1240 x 1240 pixels. Phoenix ICON wide-field infant fundus image
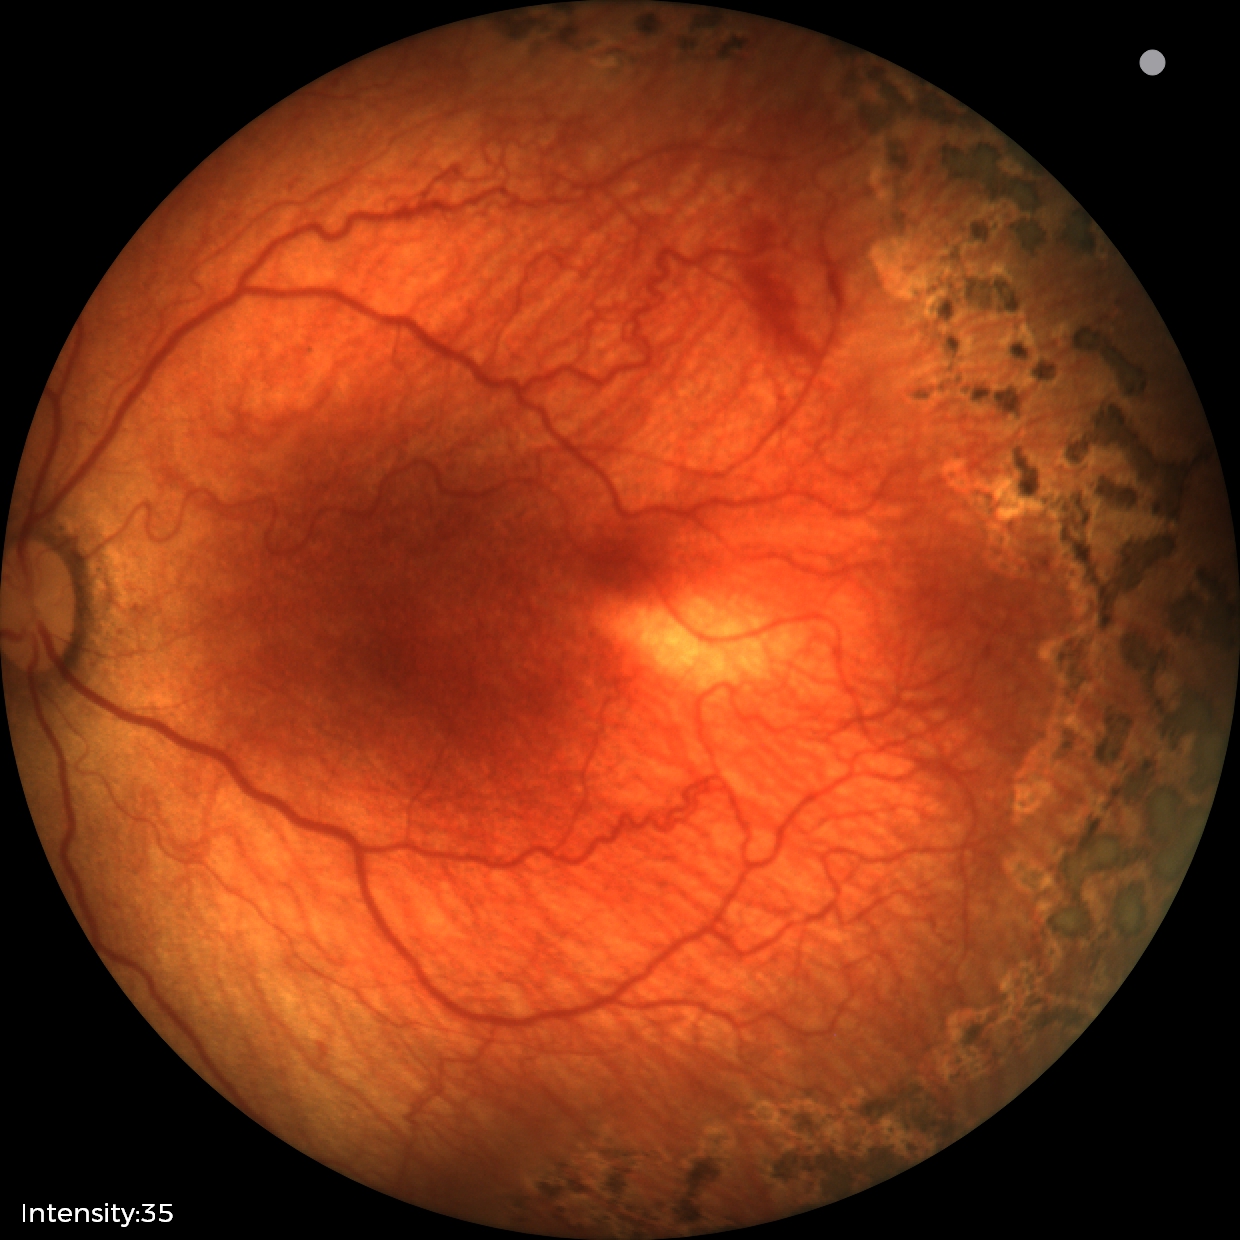
Examination diagnosed as retinopathy of prematurity stage 1. With plus disease.